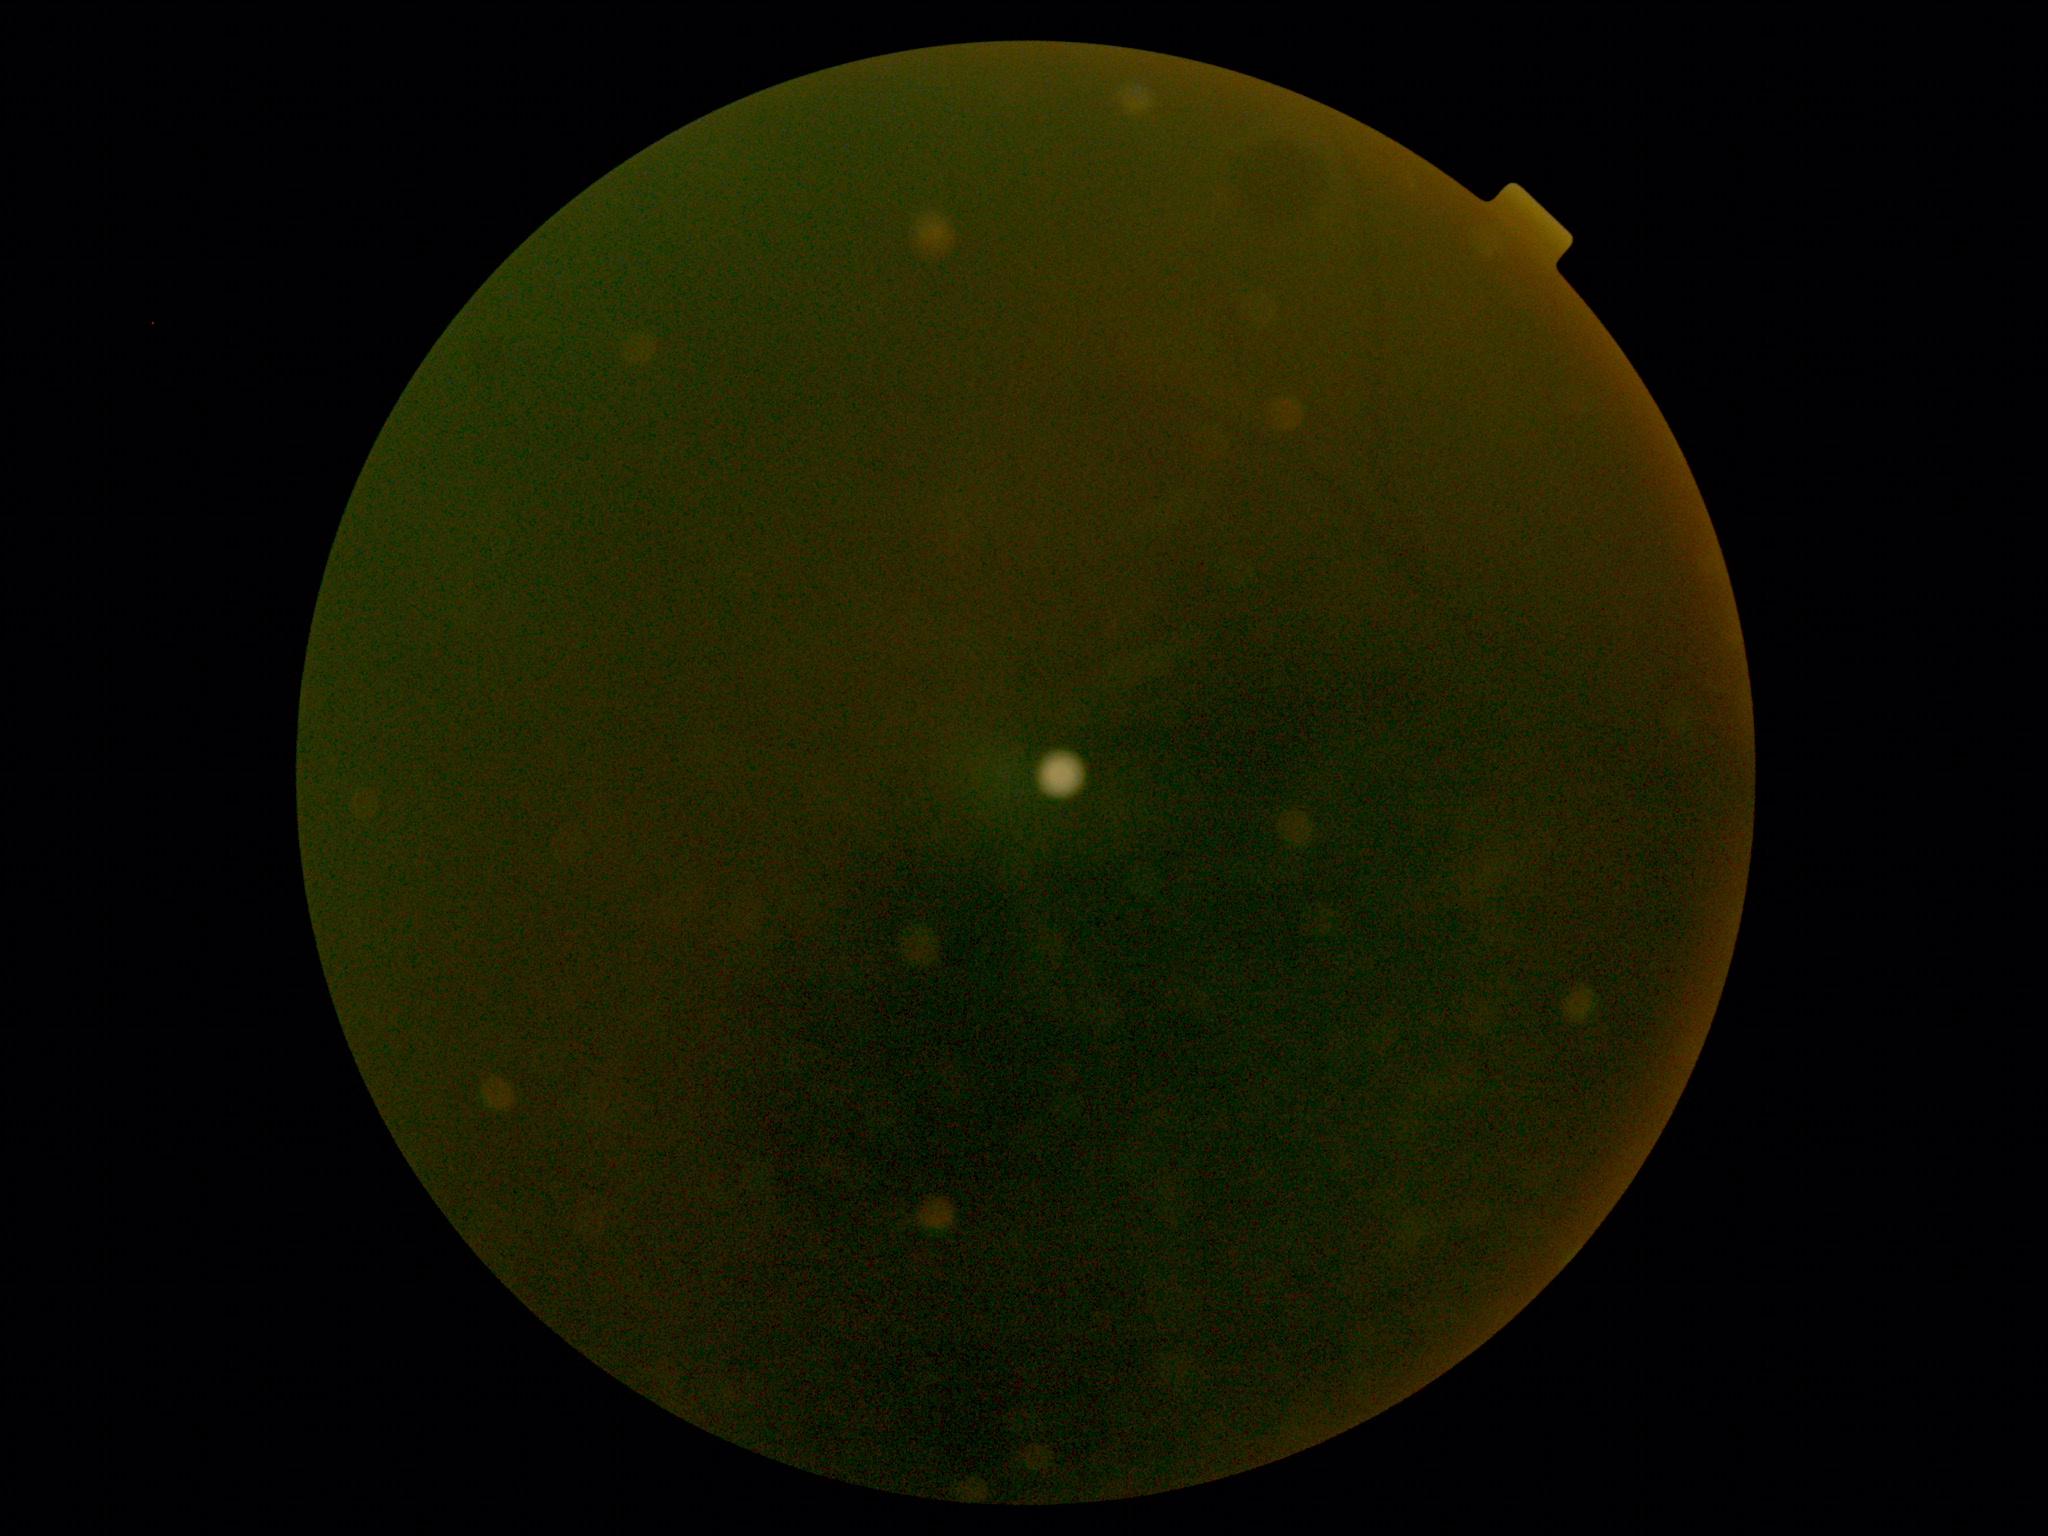
retinopathy grade = ungradable.